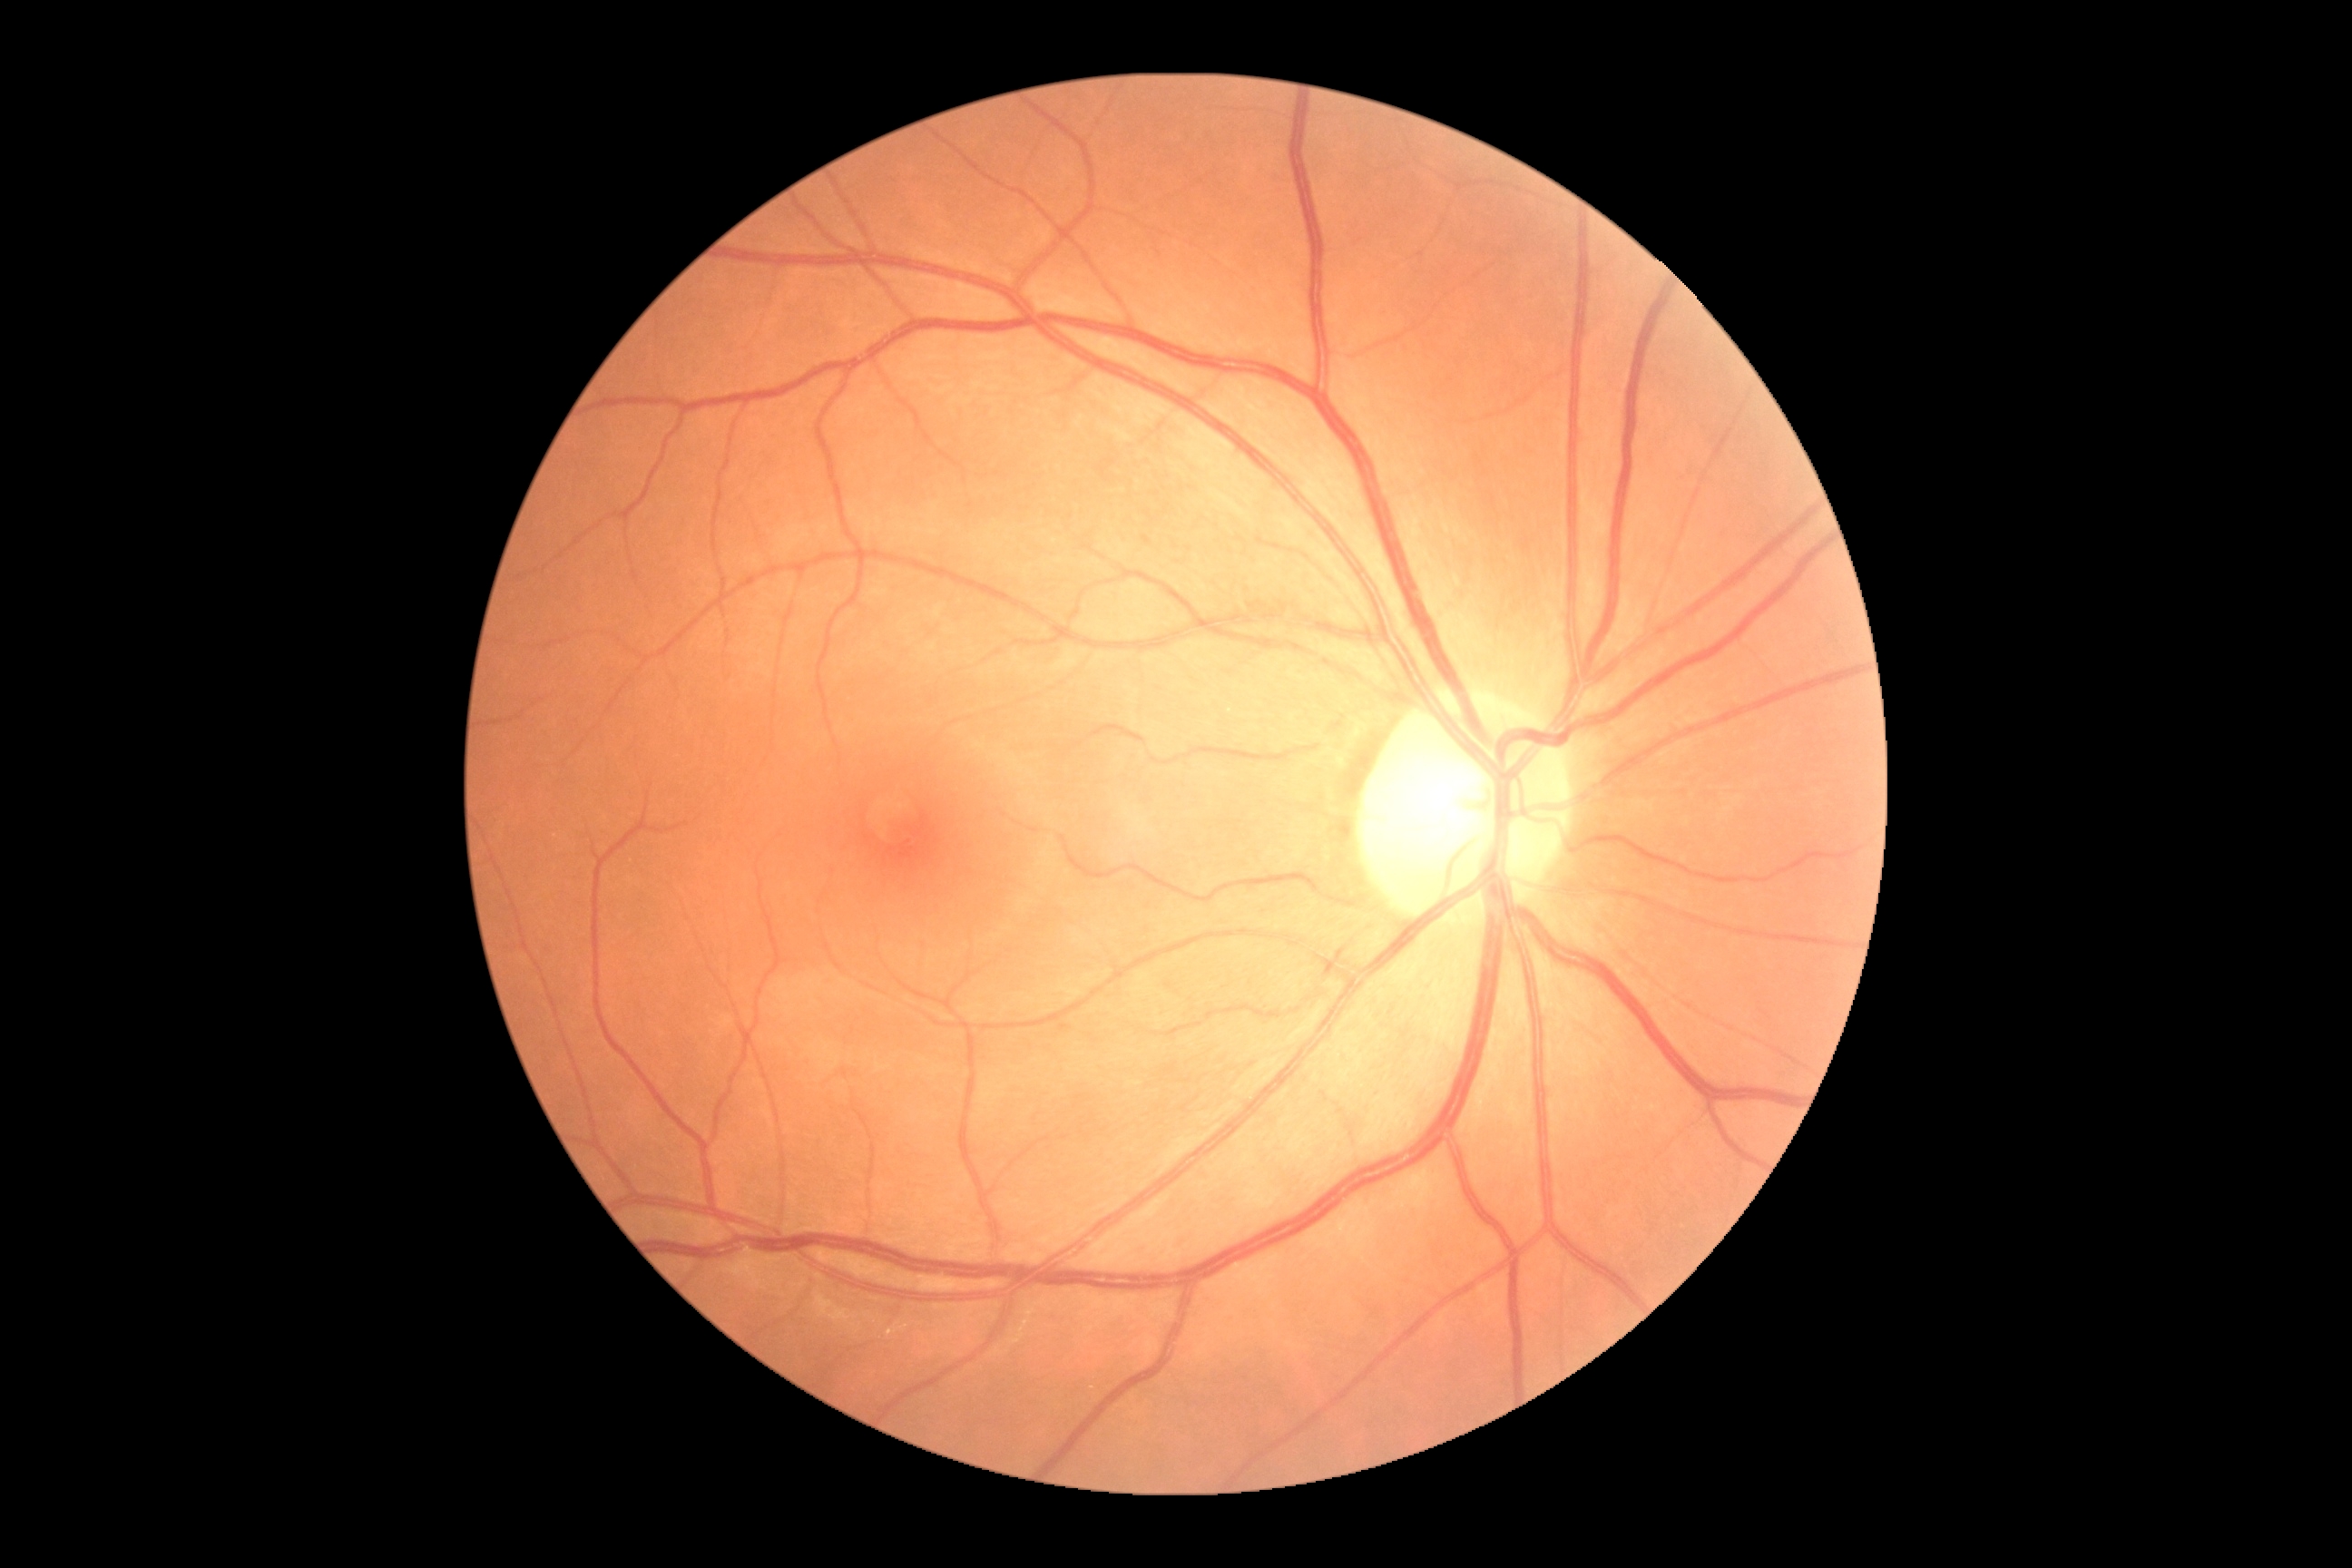
DR grade is 0.